45° FOV, color fundus photograph, 2212x1659:
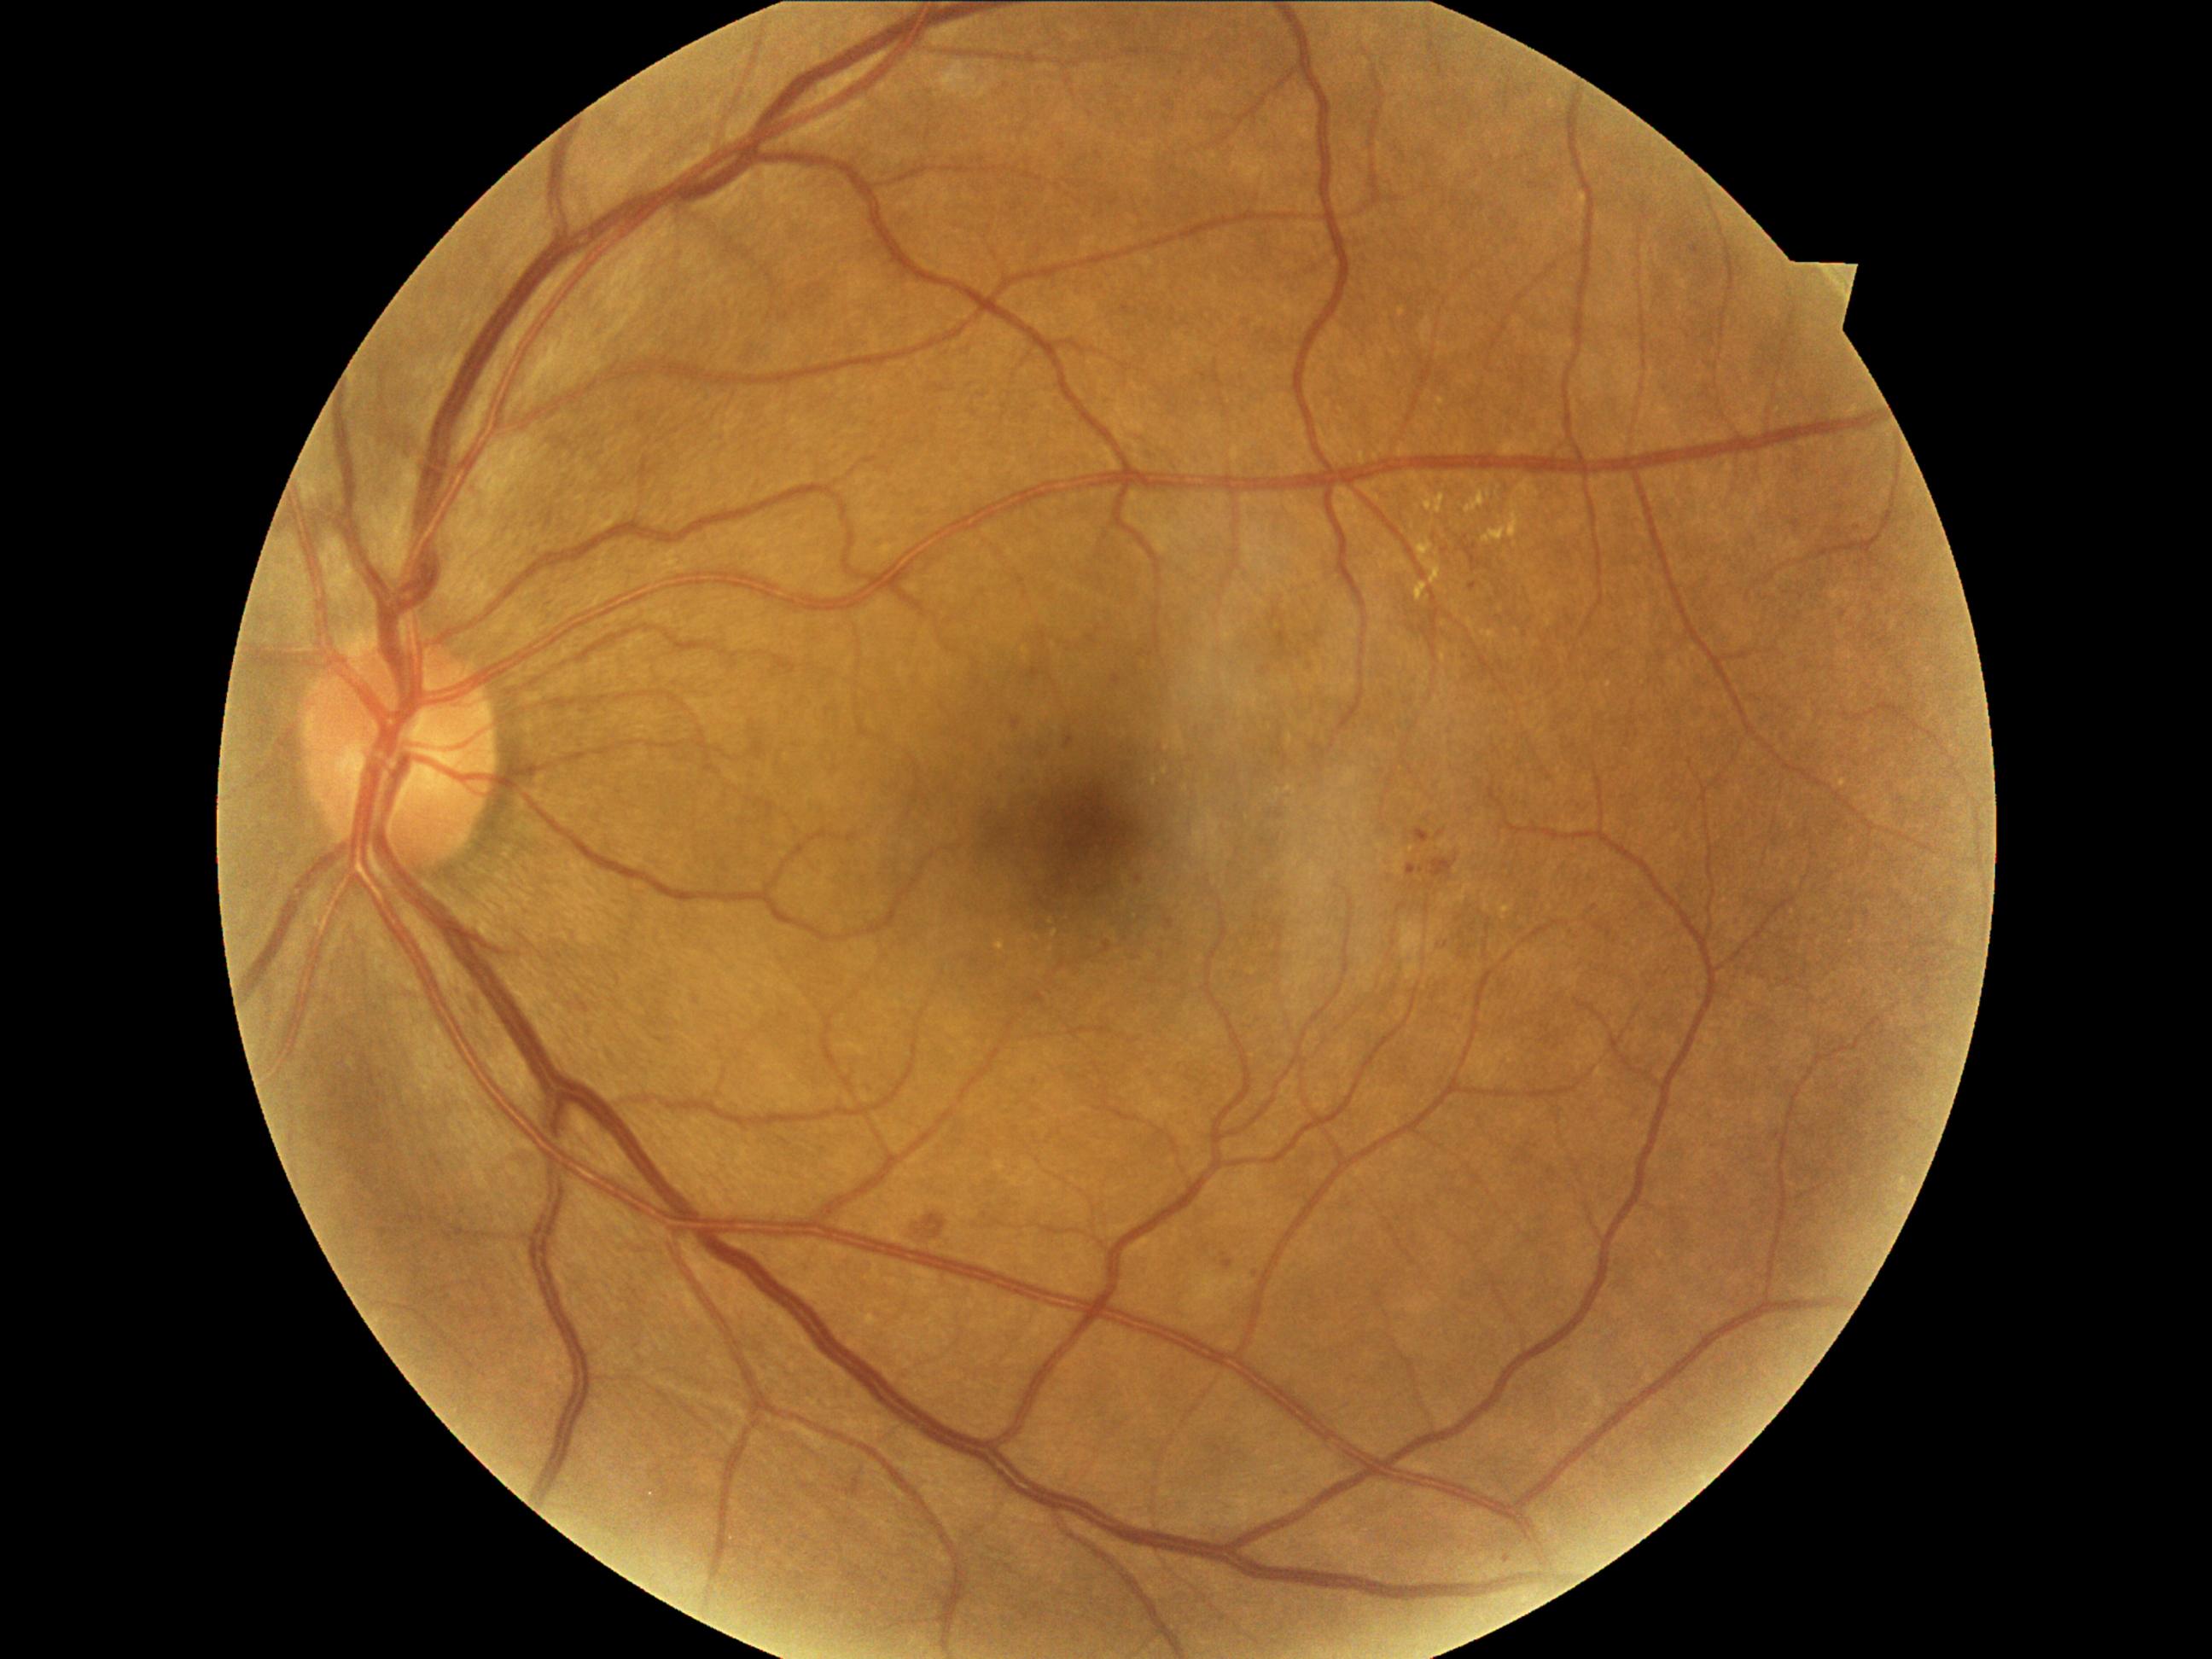 DR grade is moderate NPDR (2); non-proliferative diabetic retinopathy
Lesions identified (partial list):
HEs (more not shown): Rect(1793, 521, 1802, 530), Rect(1122, 306, 1131, 317), Rect(1213, 1443, 1223, 1453), Rect(458, 987, 506, 1062), Rect(1689, 247, 1701, 257), Rect(1066, 736, 1074, 748), Rect(863, 1081, 873, 1095), Rect(1436, 830, 1445, 839), Rect(989, 771, 1004, 784), Rect(1435, 940, 1450, 952), Rect(1044, 777, 1054, 786), Rect(1429, 859, 1457, 878), Rect(1407, 864, 1424, 876)
Additional small HEs near (x=1857, y=528), (x=1229, y=1453), (x=1844, y=614), (x=1140, y=879), (x=1446, y=551), (x=1858, y=1073), (x=1256, y=1275)
EXs (more not shown): Rect(1516, 480, 1539, 496), Rect(996, 941, 1004, 952), Rect(1438, 399, 1445, 407), Rect(1482, 503, 1522, 544), Rect(1421, 489, 1445, 515)
Additional small EXs near (x=1474, y=484), (x=1608, y=685), (x=1167, y=749), (x=1055, y=934), (x=1489, y=496), (x=1165, y=772)
SEs: not present
MAs: not present